Acquired on the Clarity RetCam 3; 640x480; RetCam wide-field infant fundus image
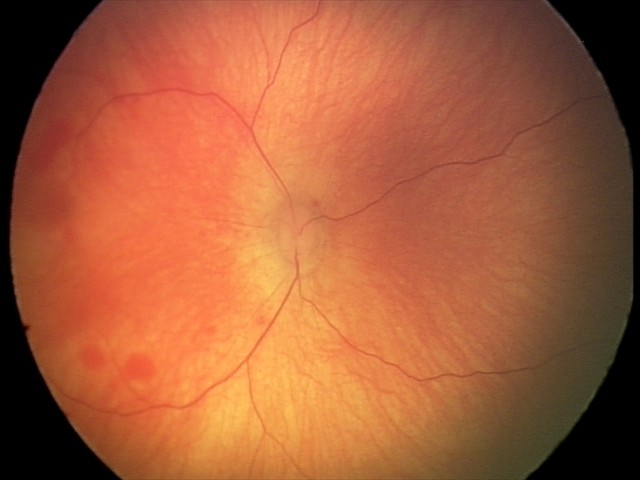
Series diagnosed as retinal hemorrhages.